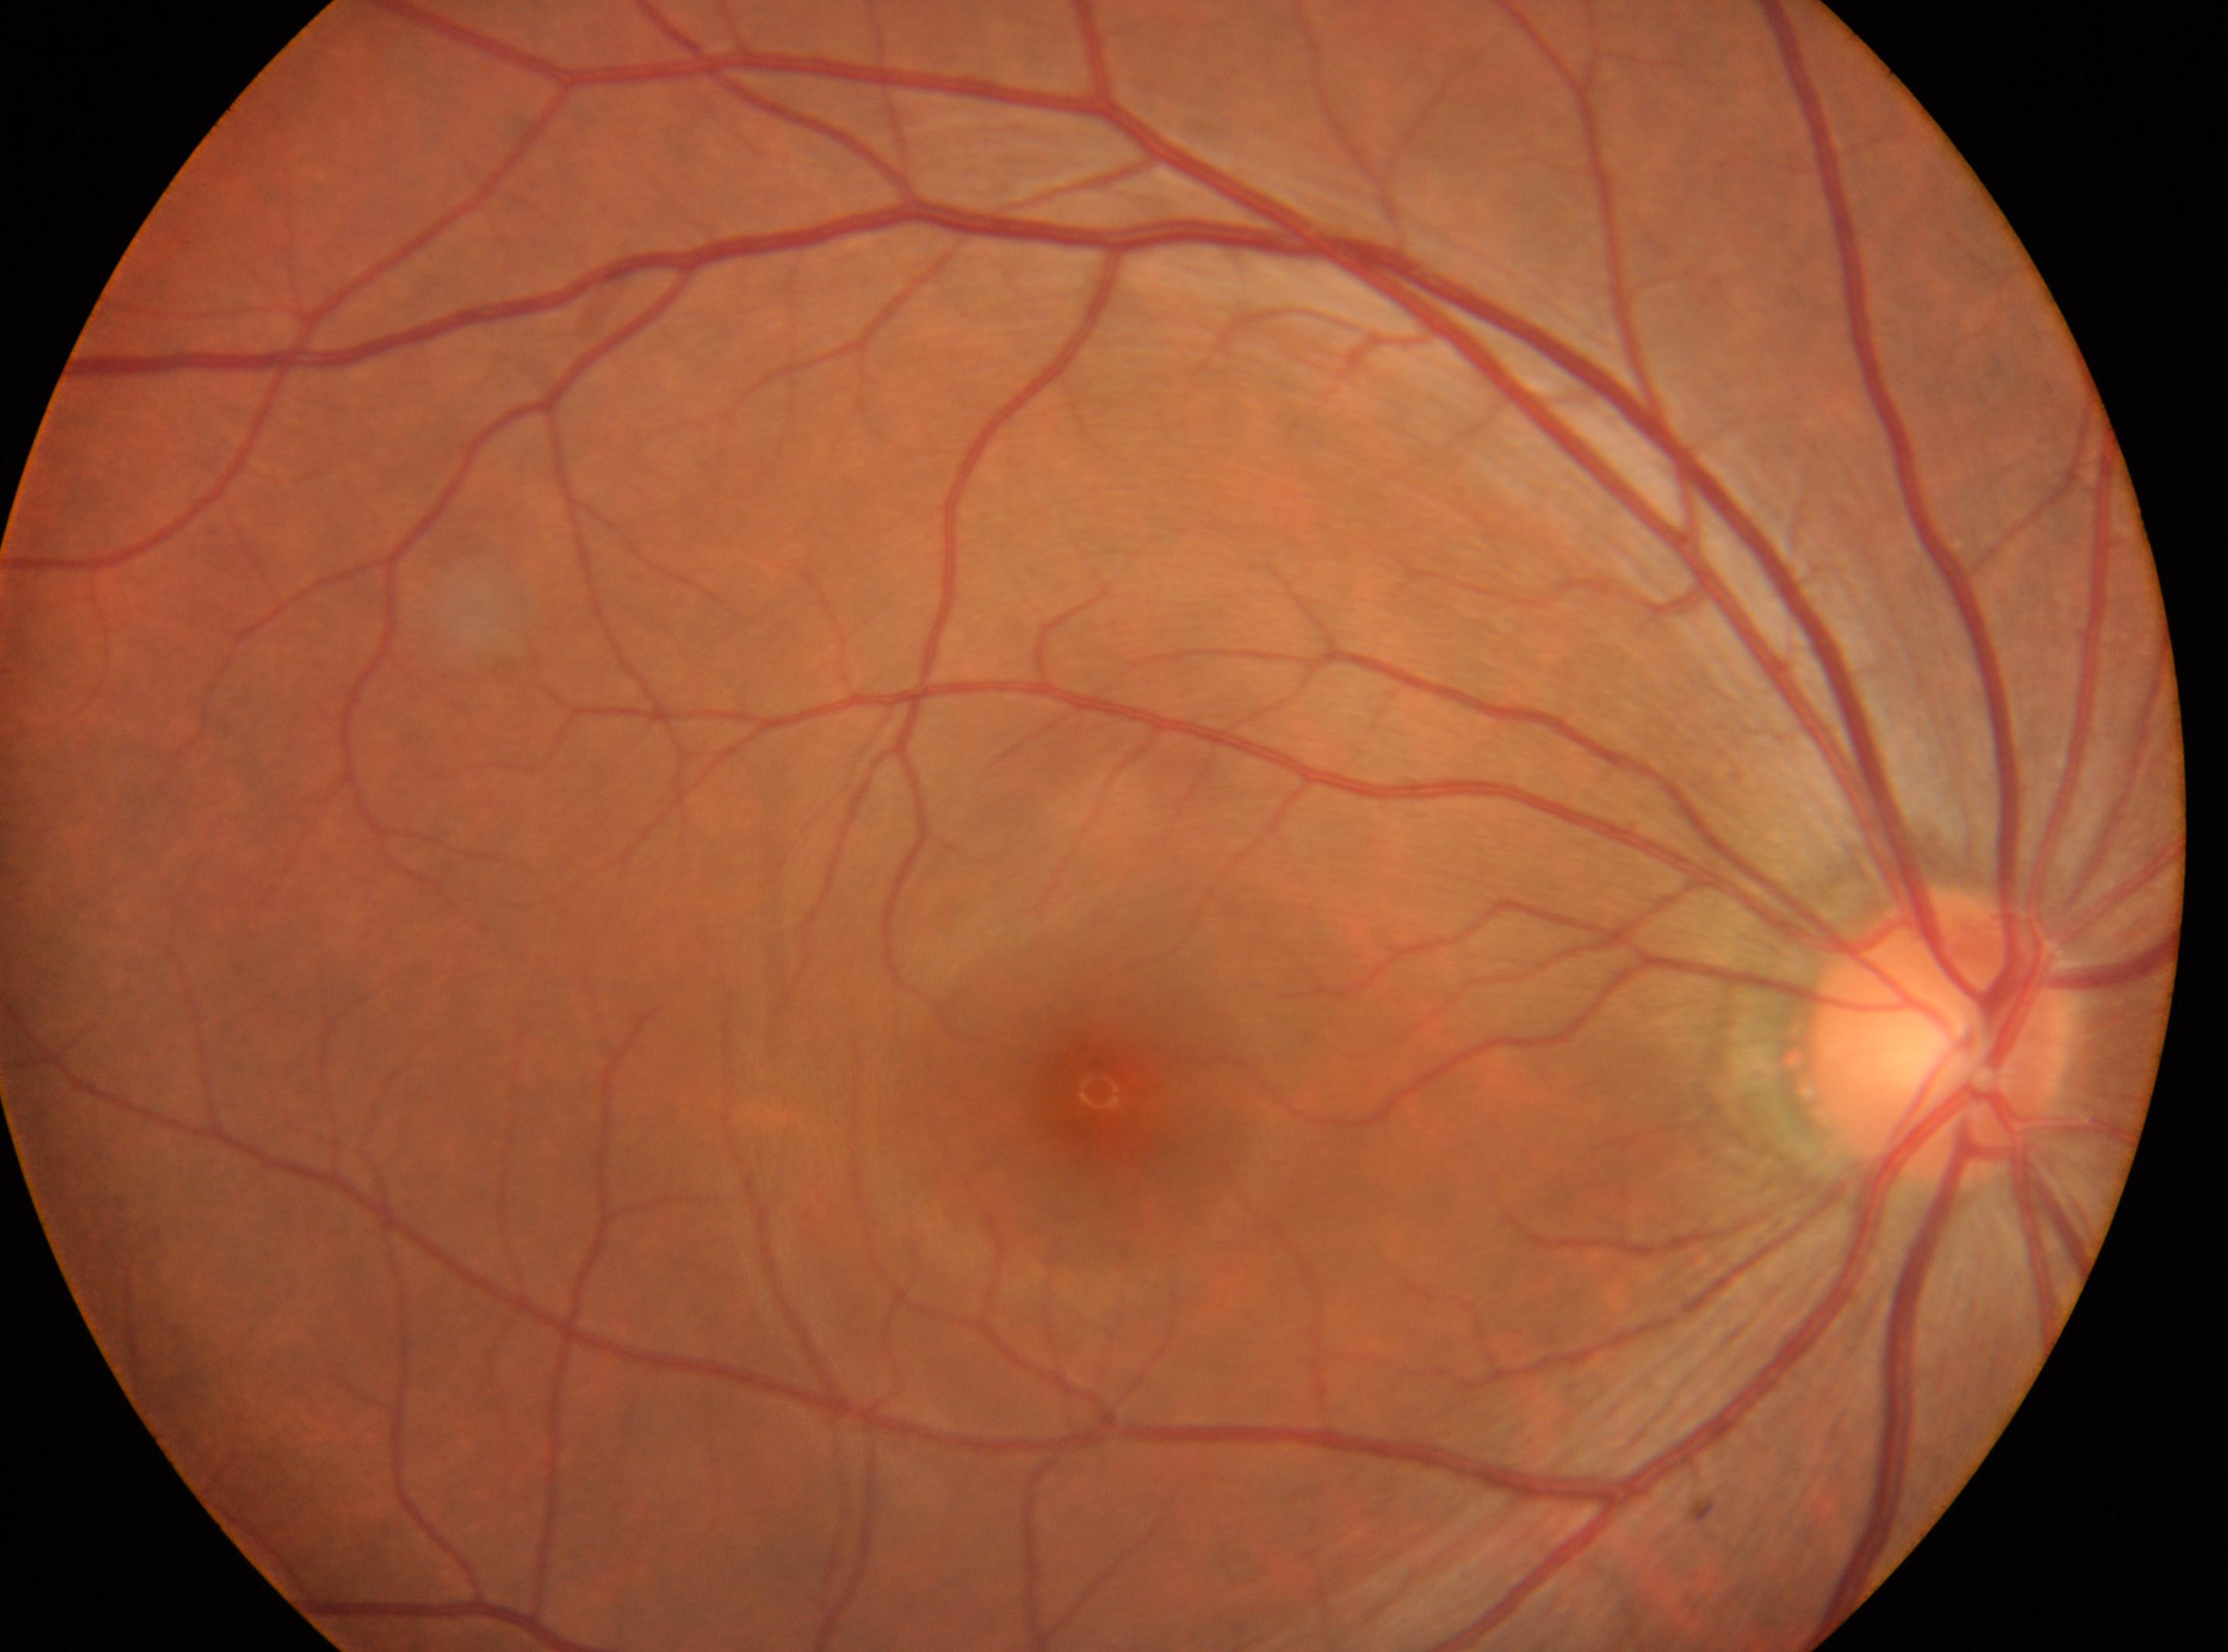 The optic disk is at x=1942, y=1036.
Foveal center: x=1099, y=1091.
No signs of diabetic retinopathy.
Imaged eye: right.
Diabetic retinopathy (DR): grade 0 (no apparent retinopathy).